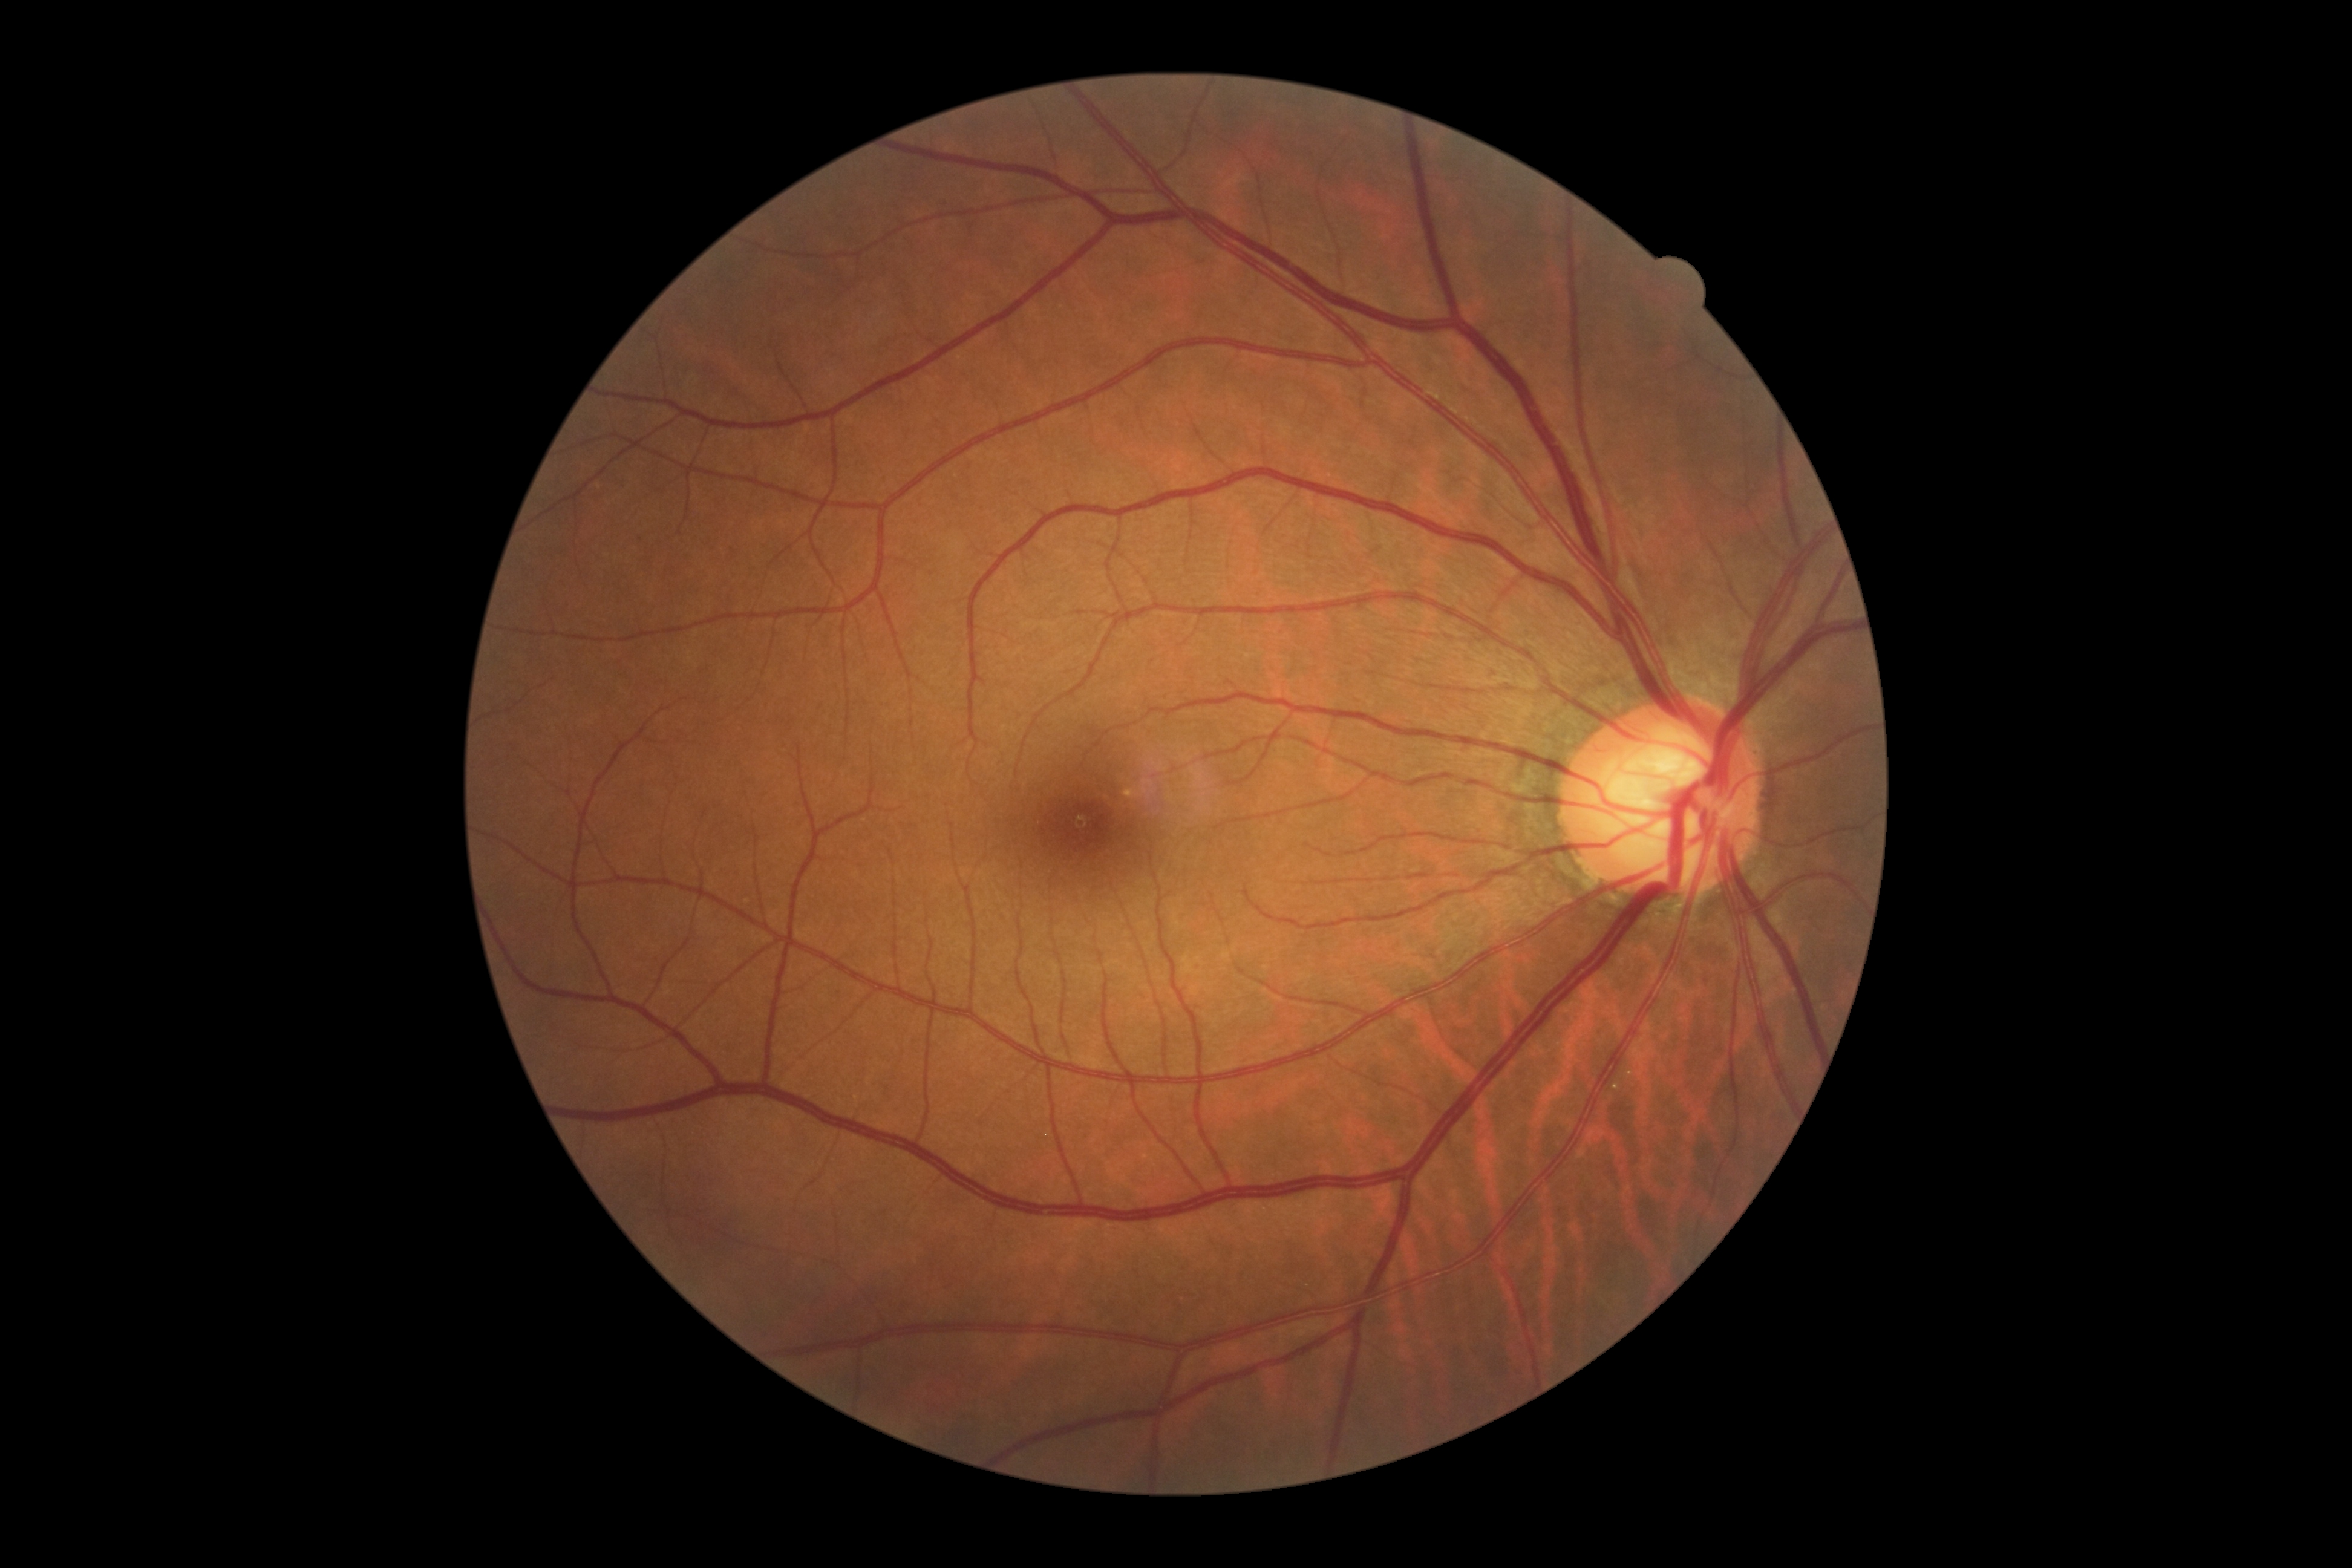

Retinopathy grade: no apparent retinopathy (0).